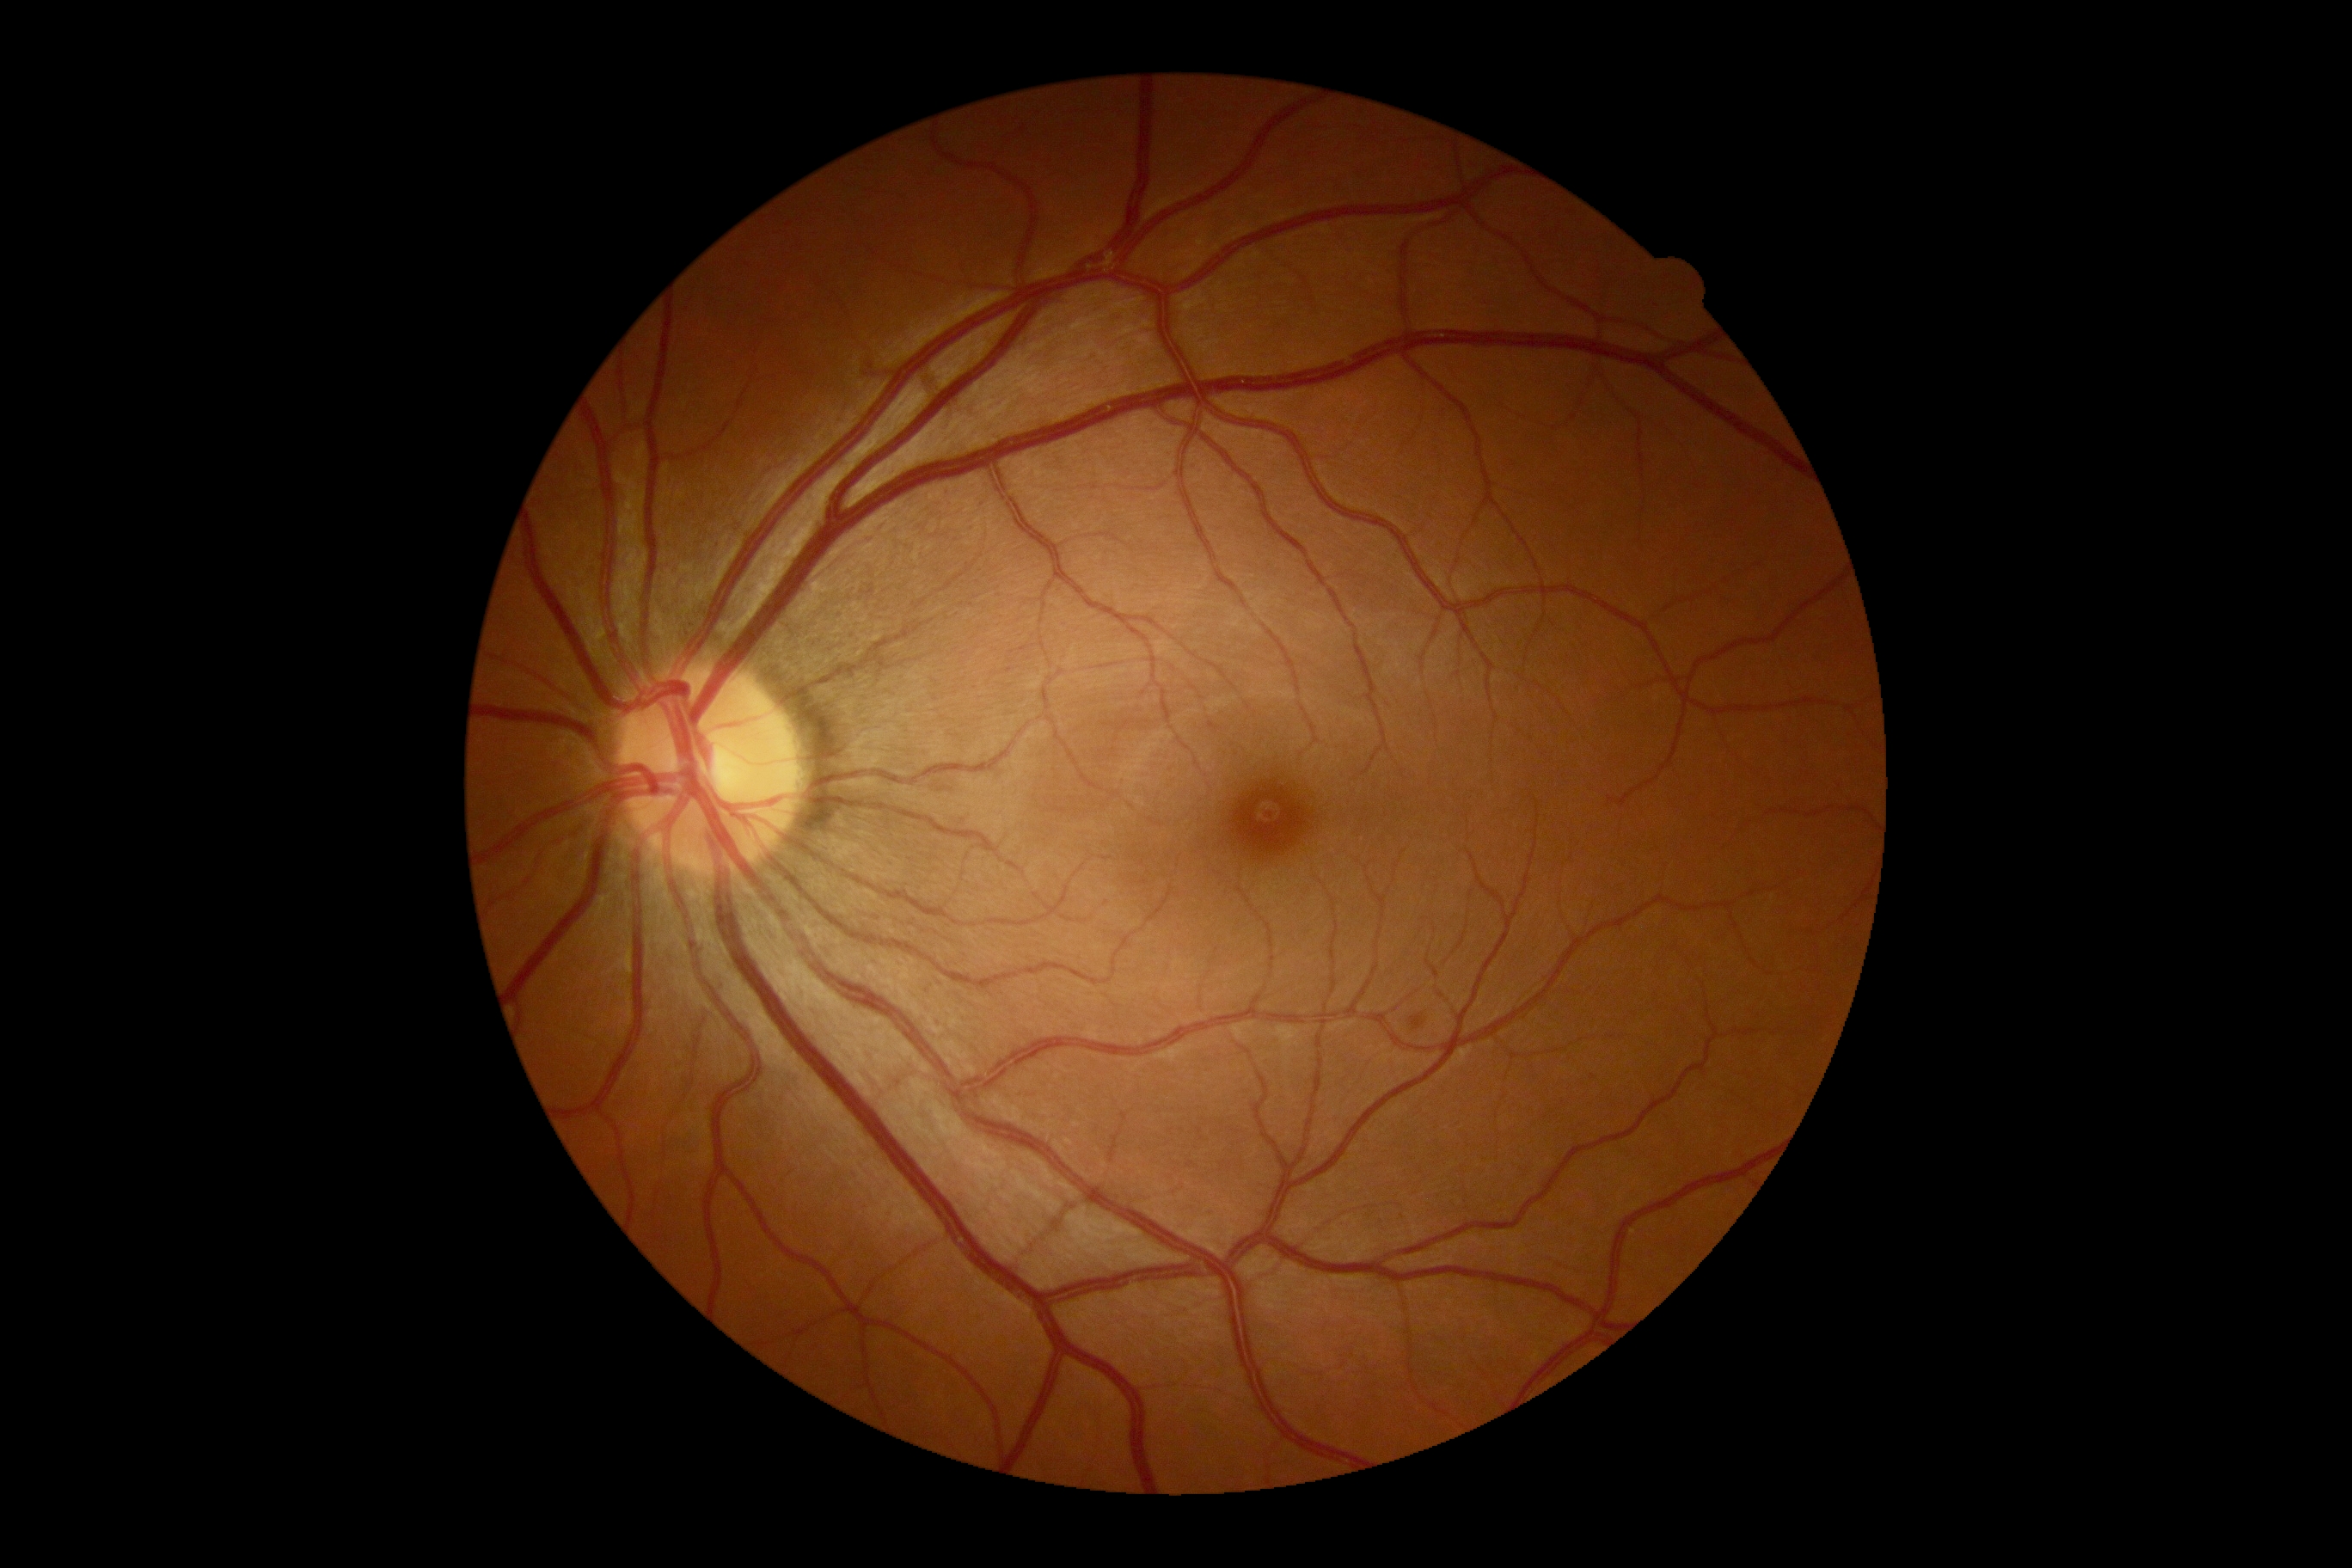
DR severity=grade 2 (moderate NPDR) — more than just microaneurysms but less than severe NPDR.